Captured on a Canon CR-1 fundus camera.
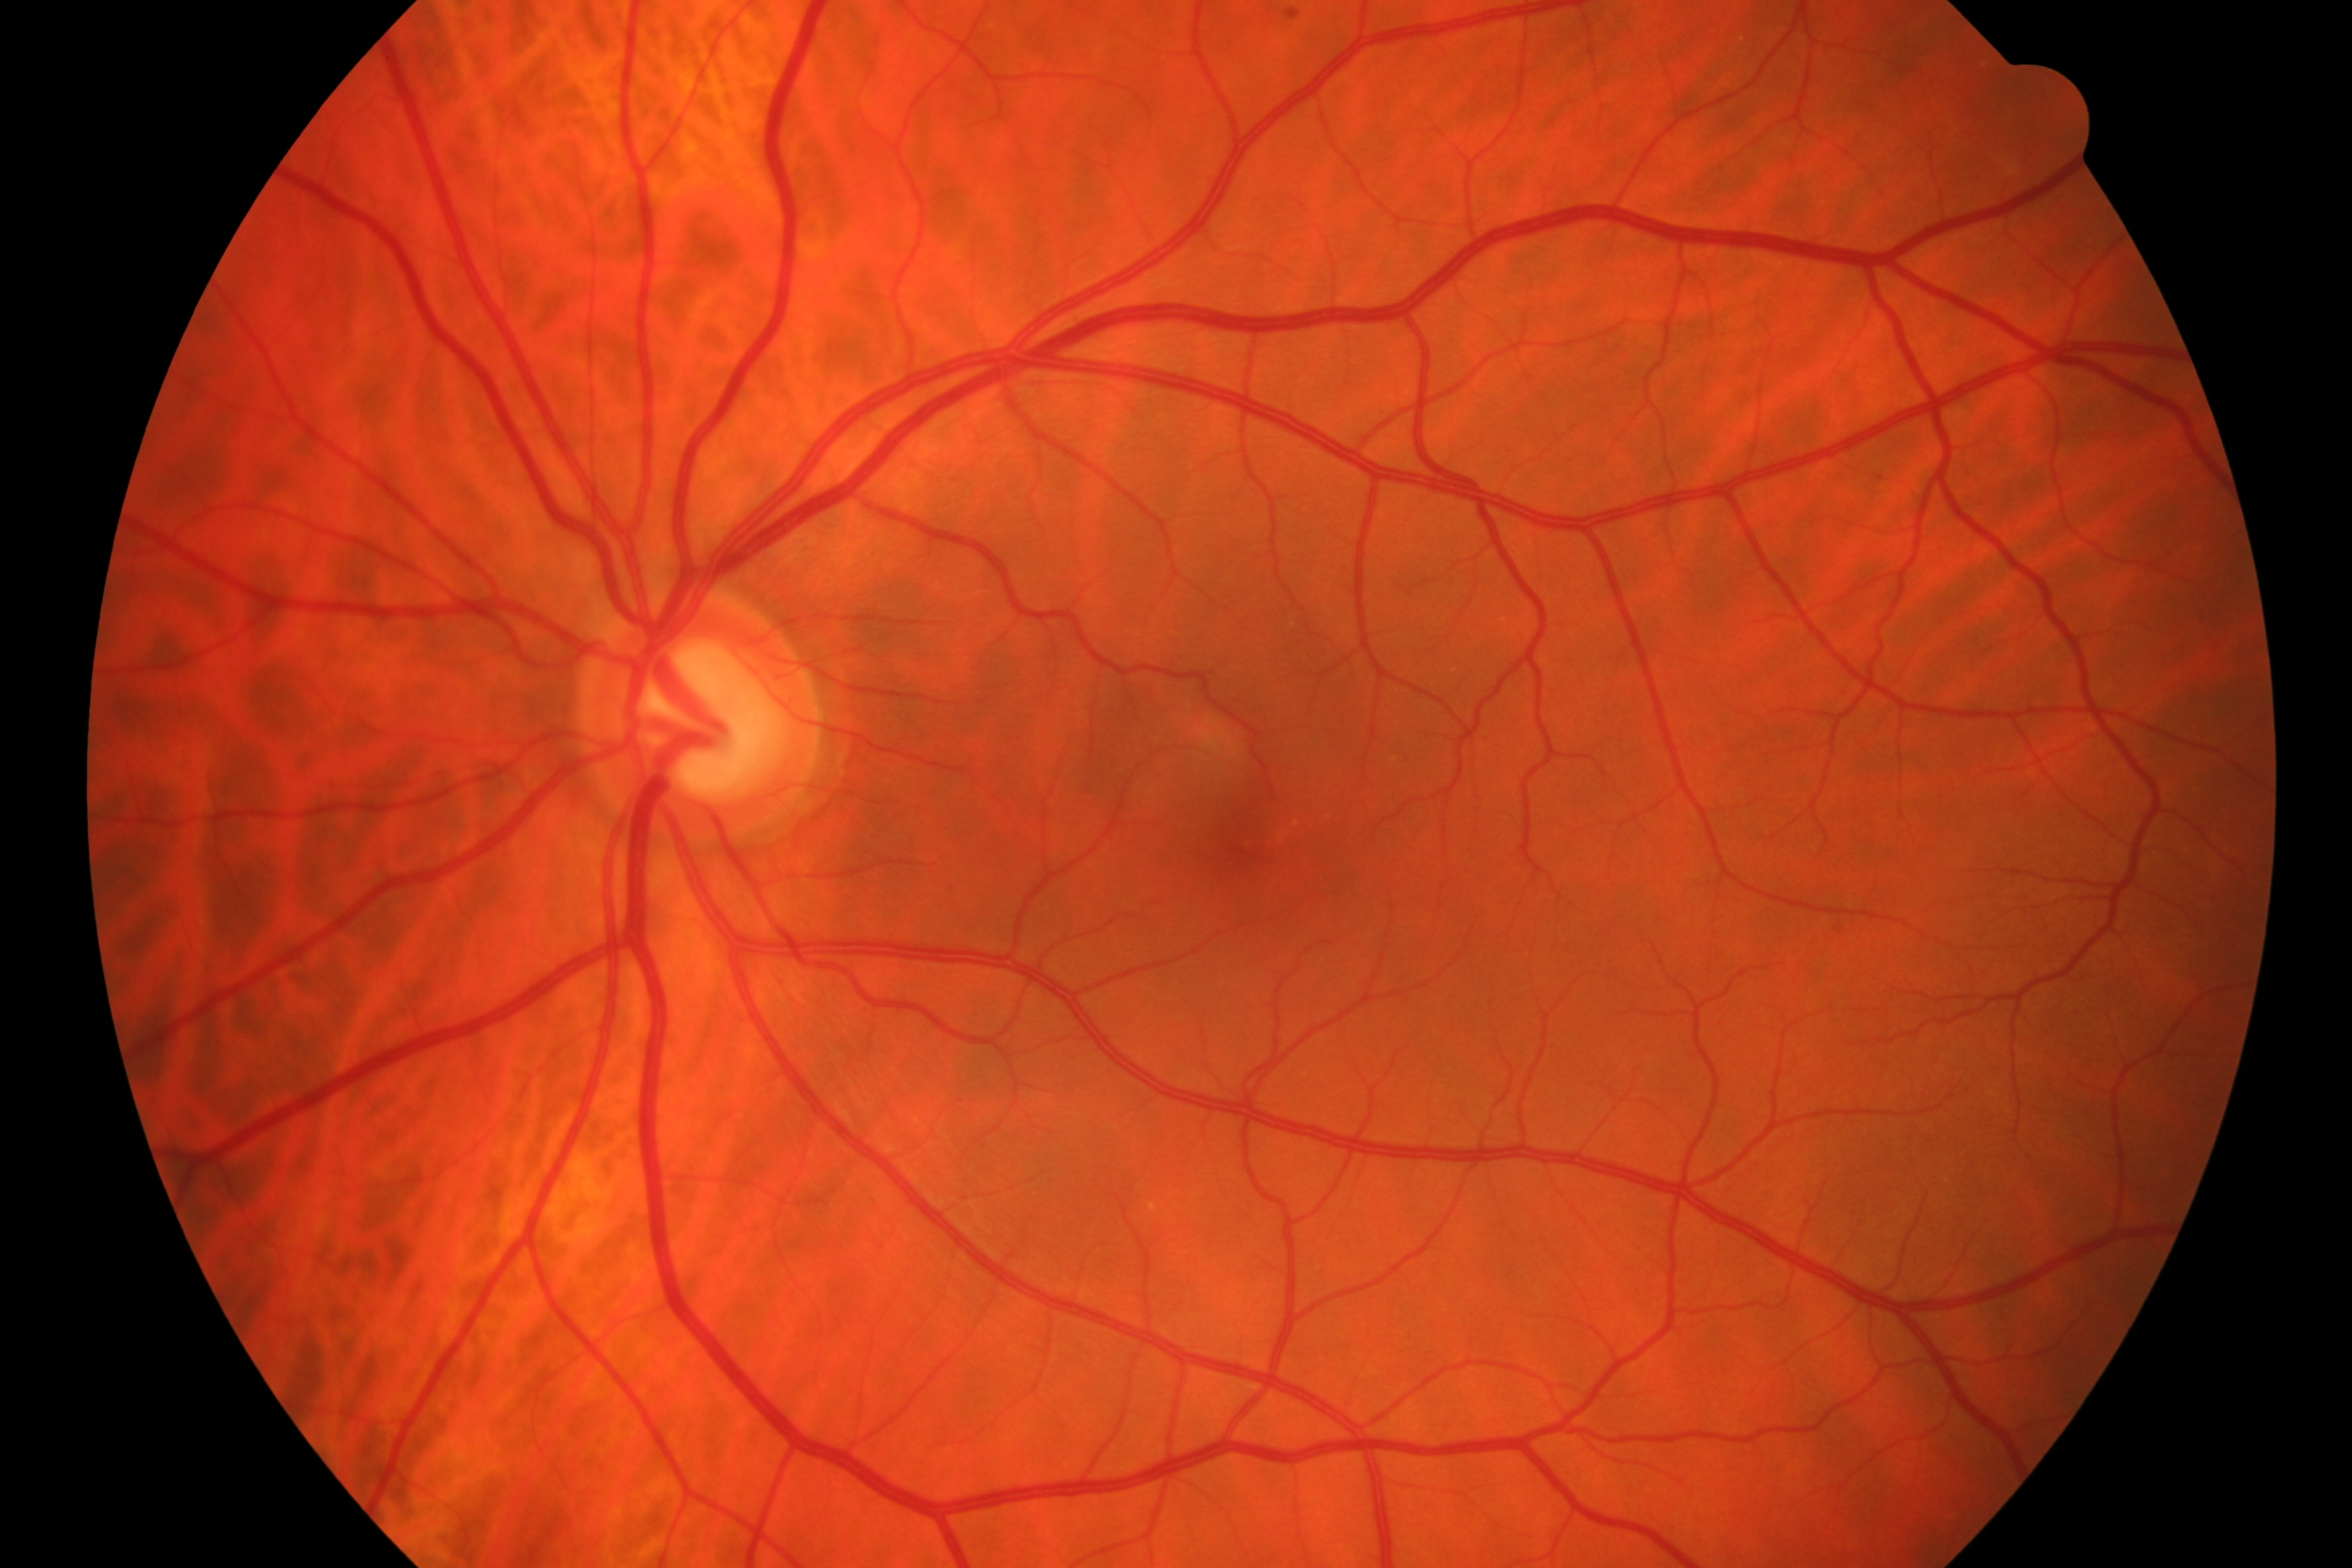

Findings consistent with glaucomatous optic neuropathy.